2048x1536 — 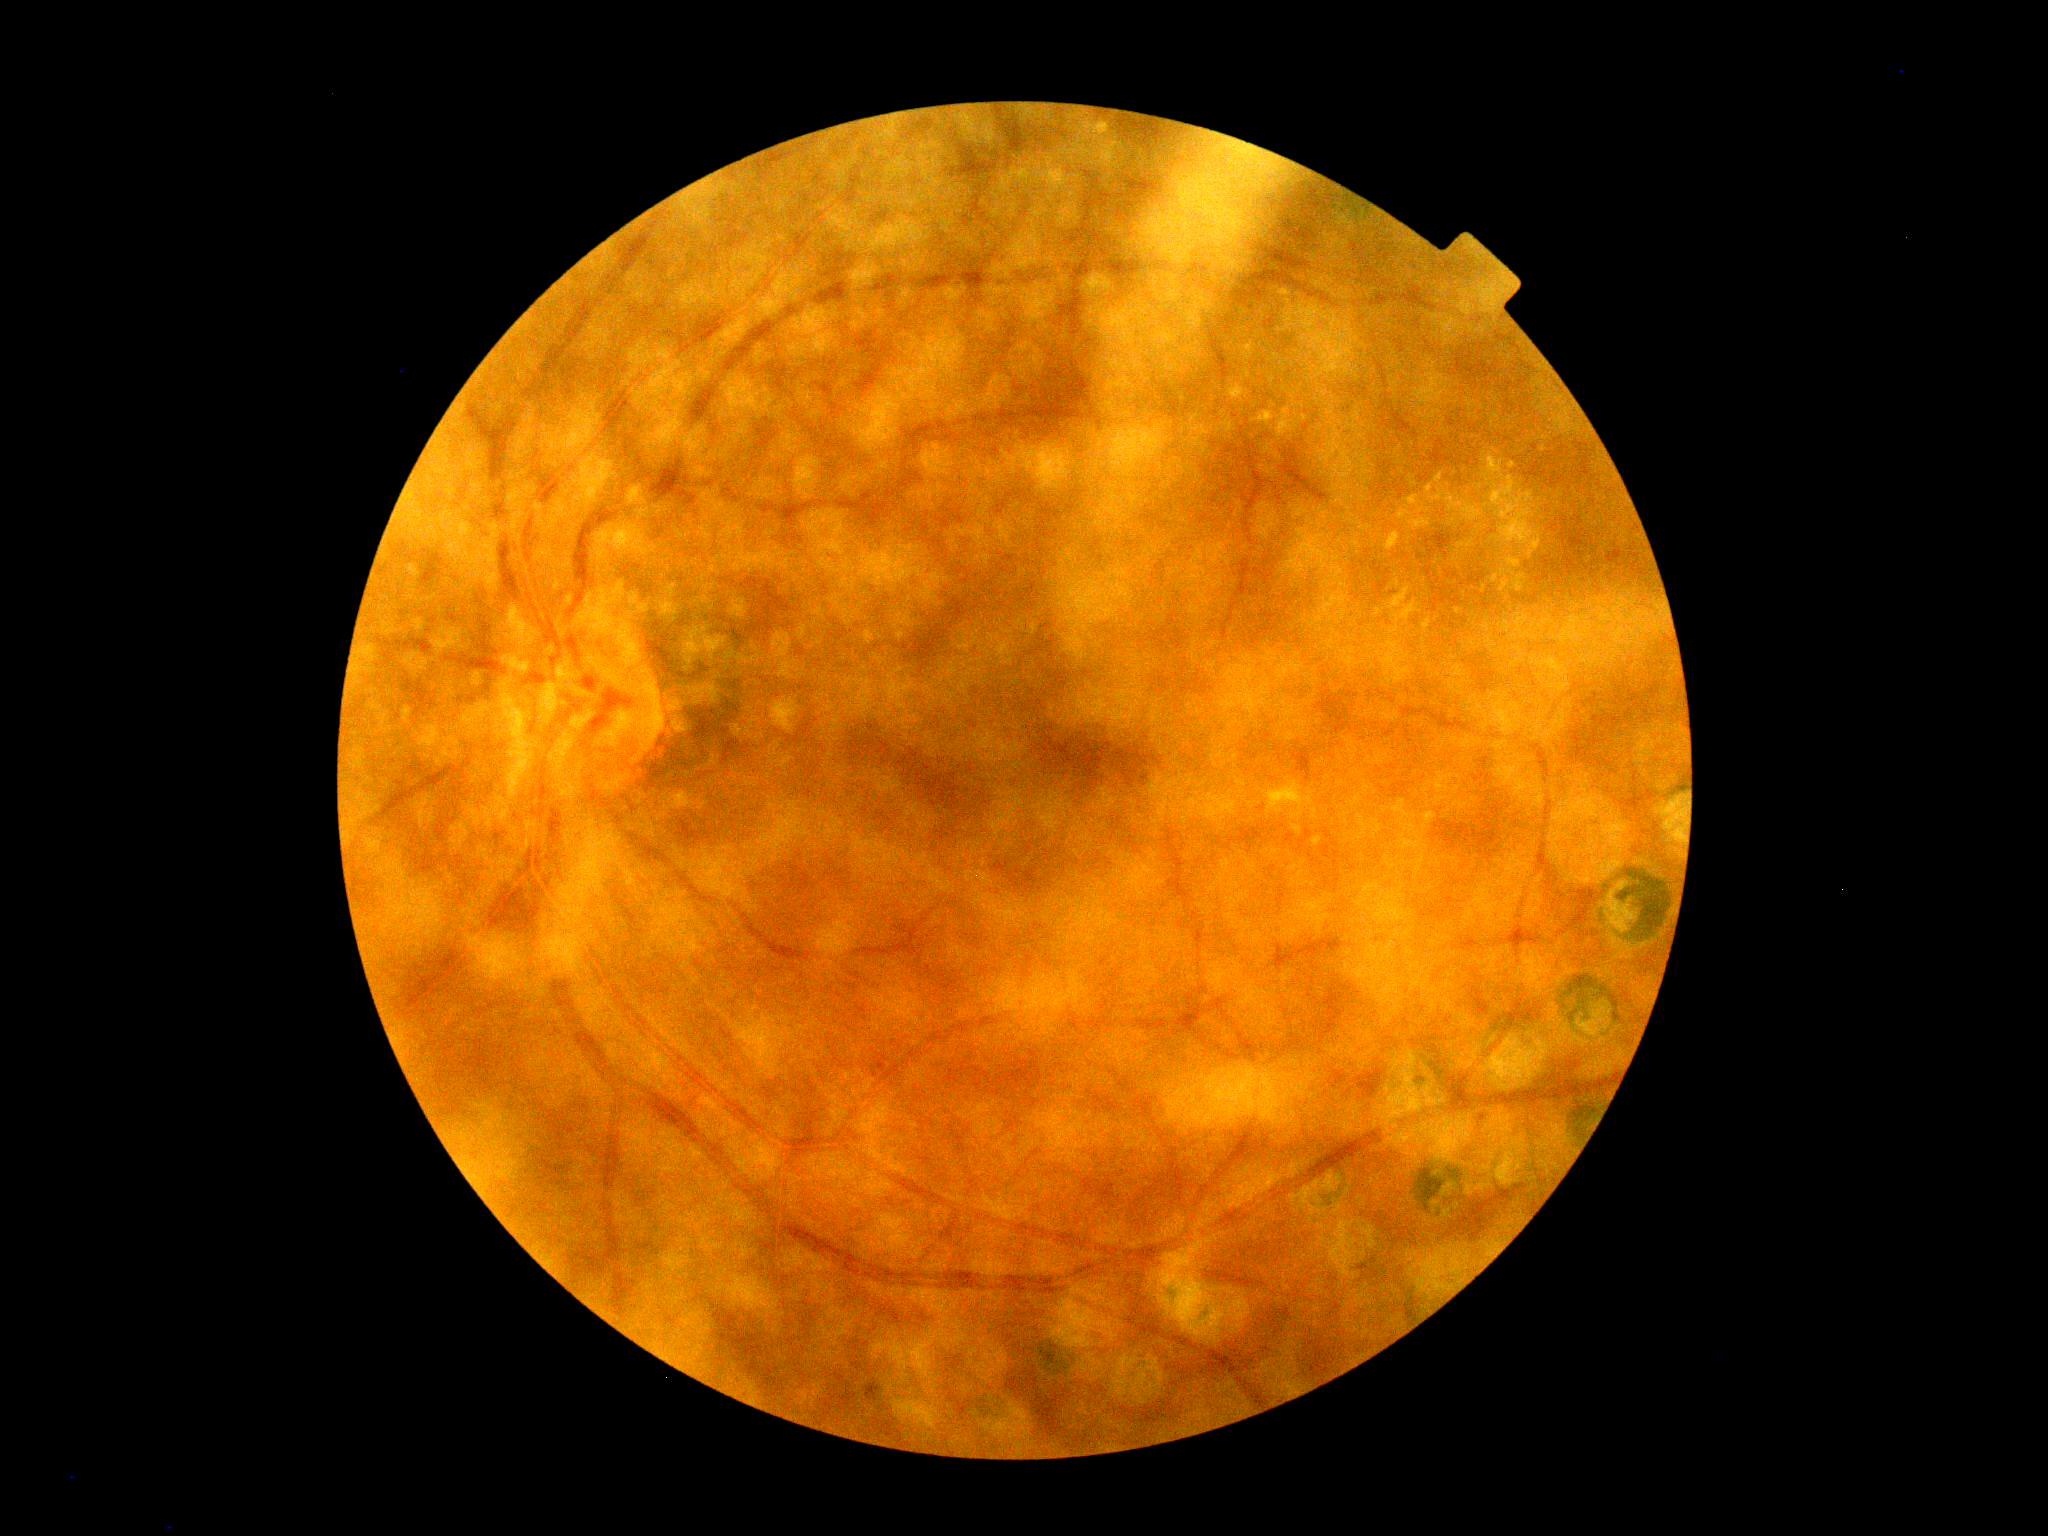

Disease class: non-proliferative diabetic retinopathy.
Diabetic retinopathy (DR): 2/4.